Fundus photo:
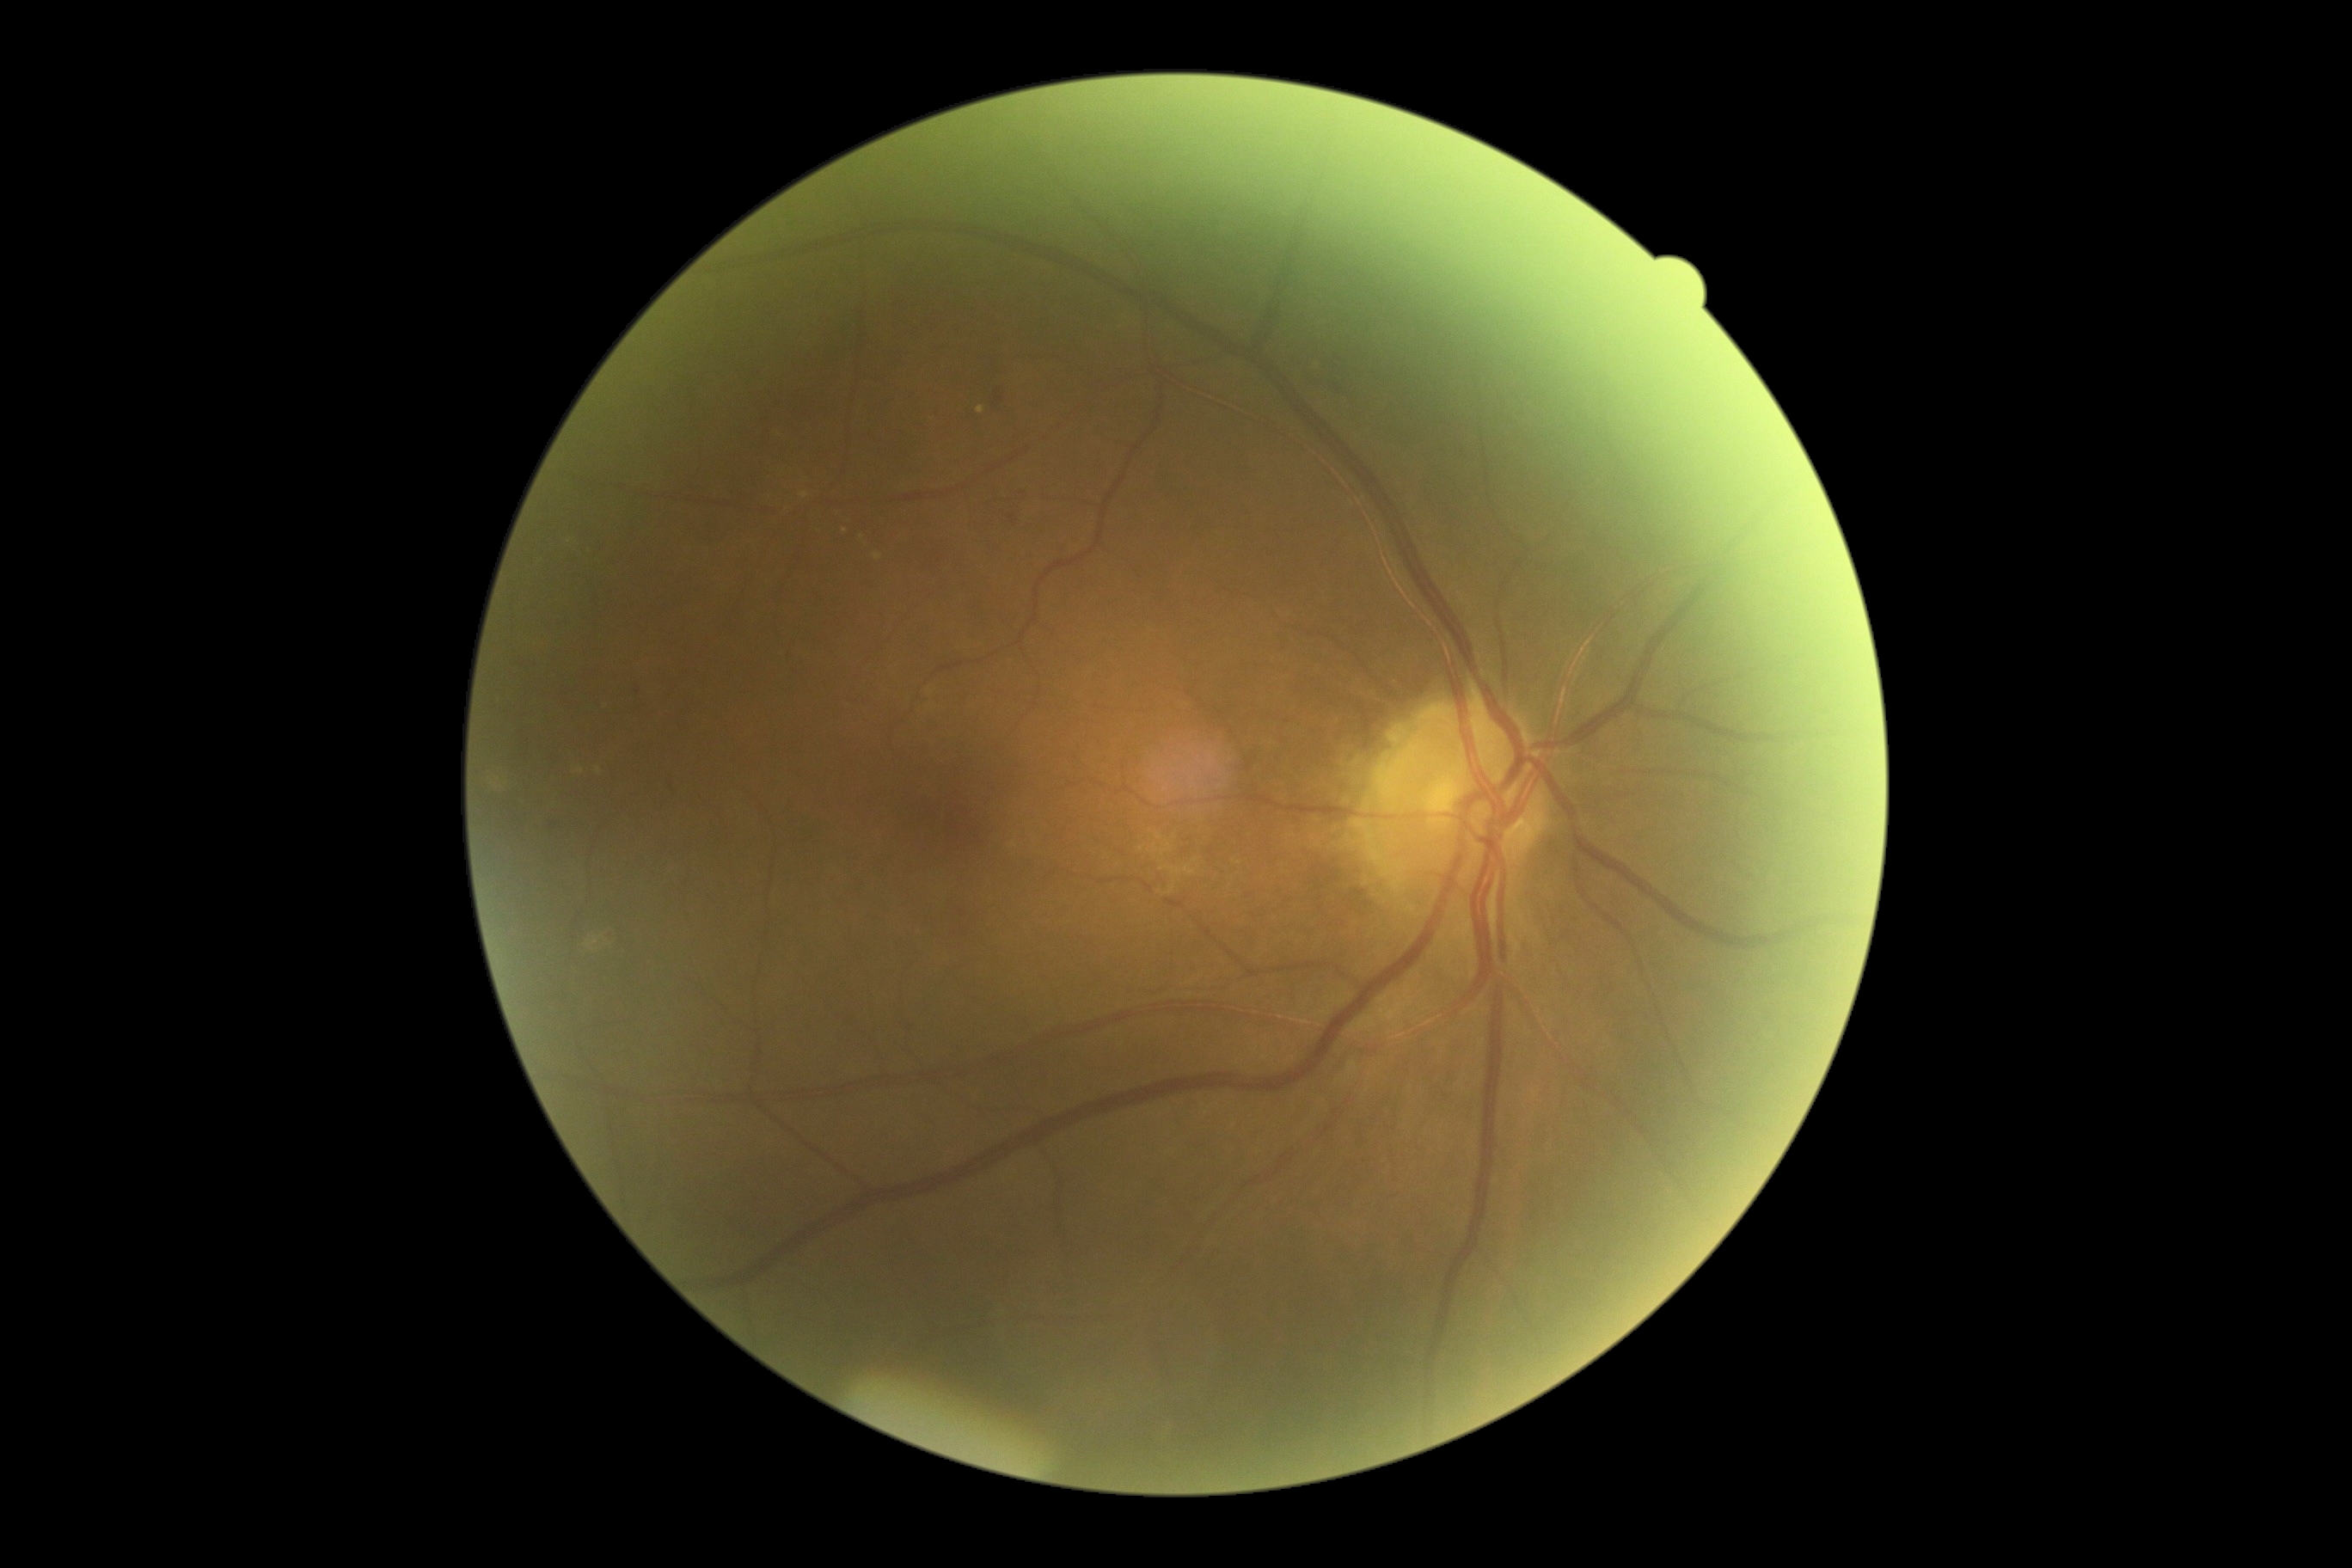
dr_grade: 2